364x364; color fundus photograph centered on the optic disc: 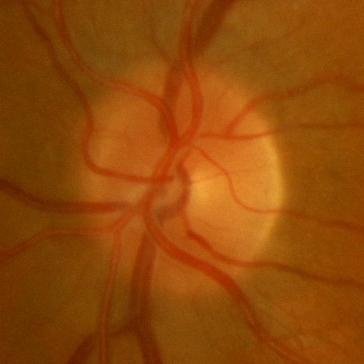 Finding = no evidence of glaucoma.